Fundus photo
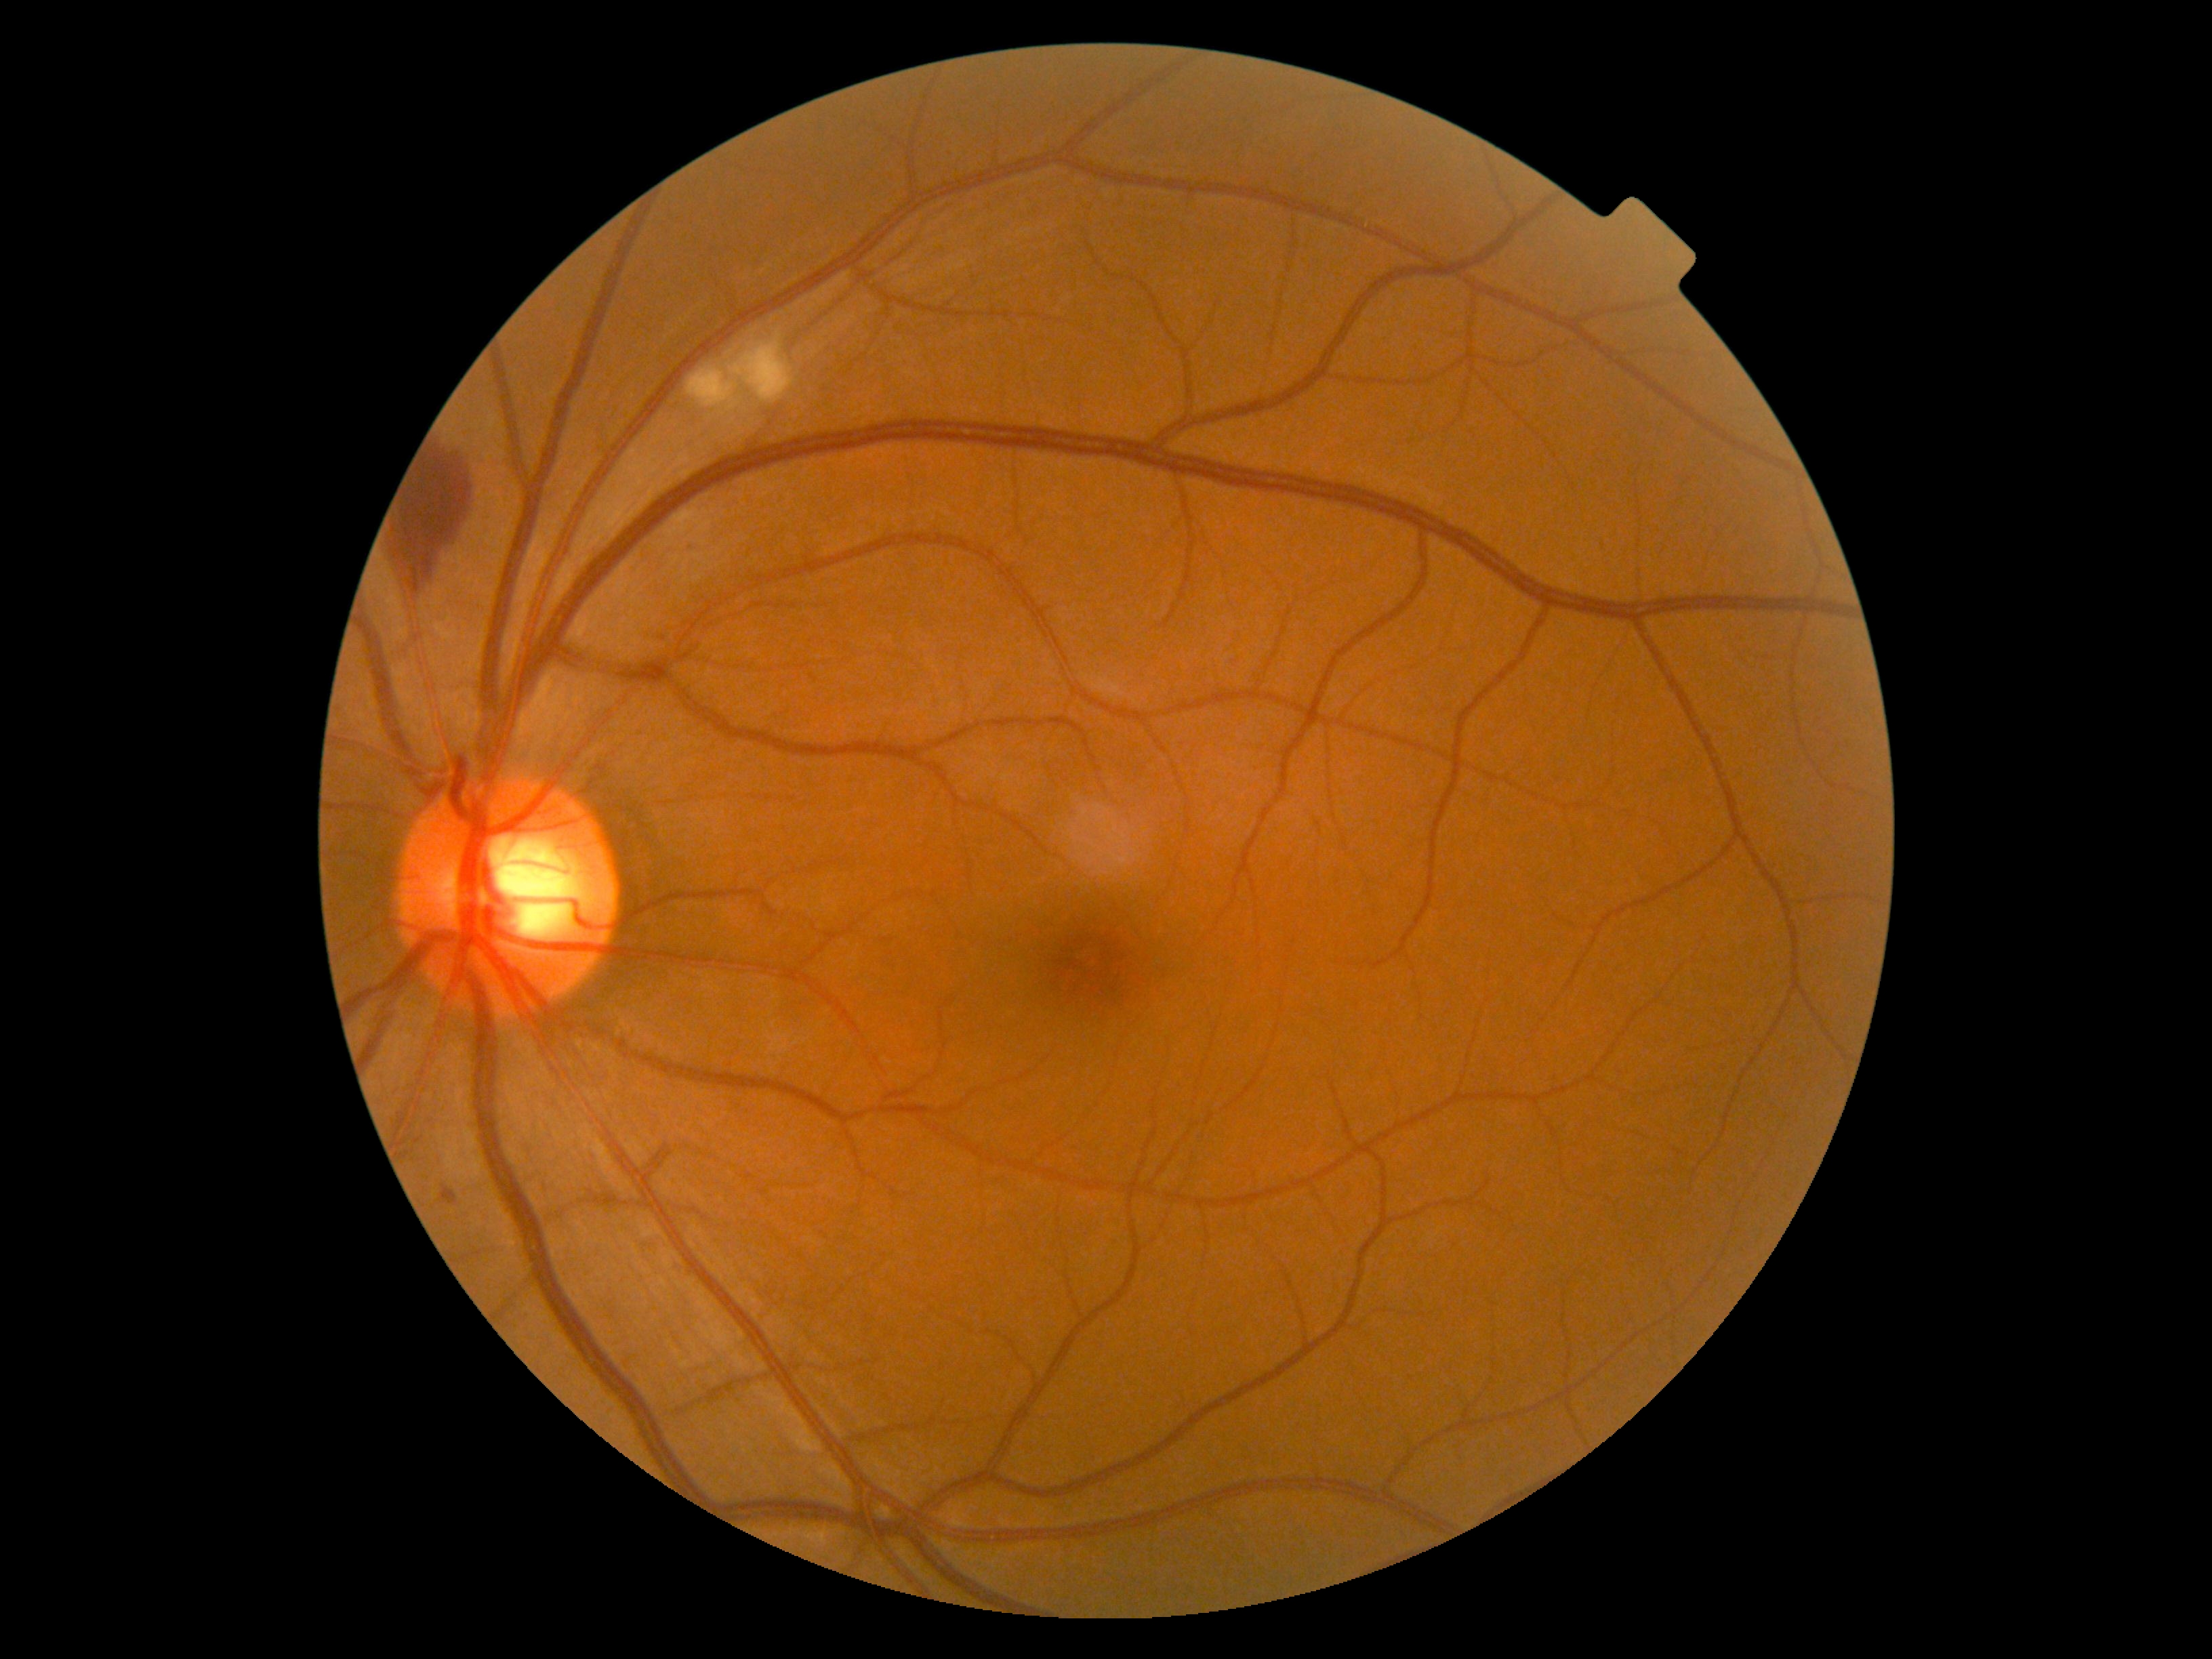

DR grade is moderate non-proliferative diabetic retinopathy (2) — more than just microaneurysms but less than severe NPDR.